848 by 848 pixels, camera: NIDEK AFC-230, 45° field of view, nonmydriatic fundus photograph, CFP: 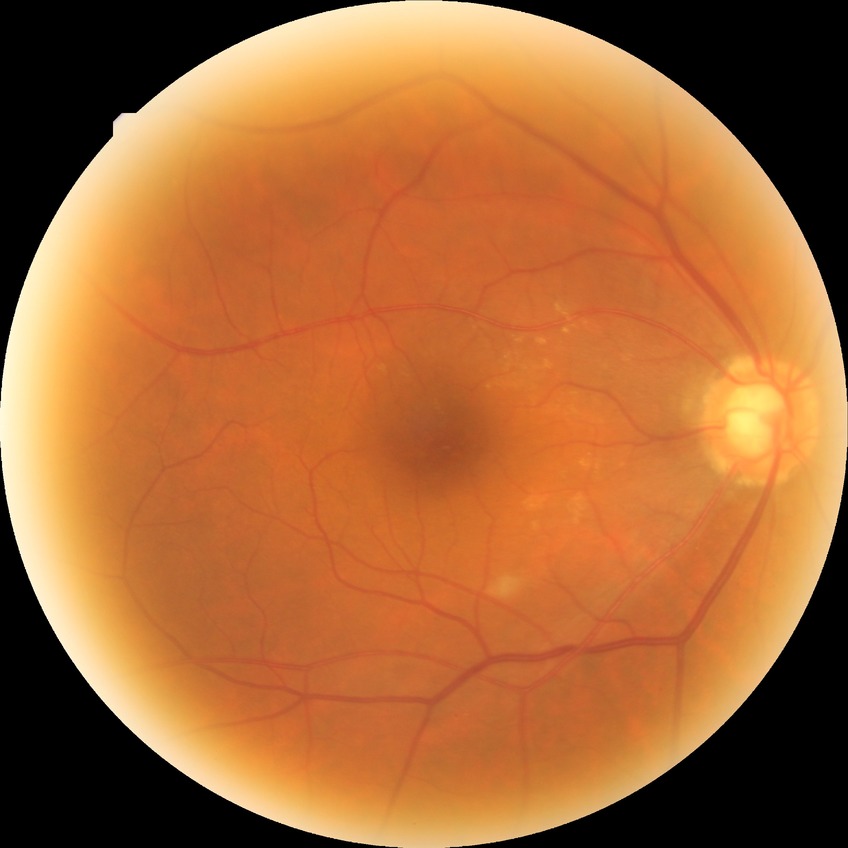

DR impression: no apparent DR | DR stage: NDR.